DR severity per modified Davis staging
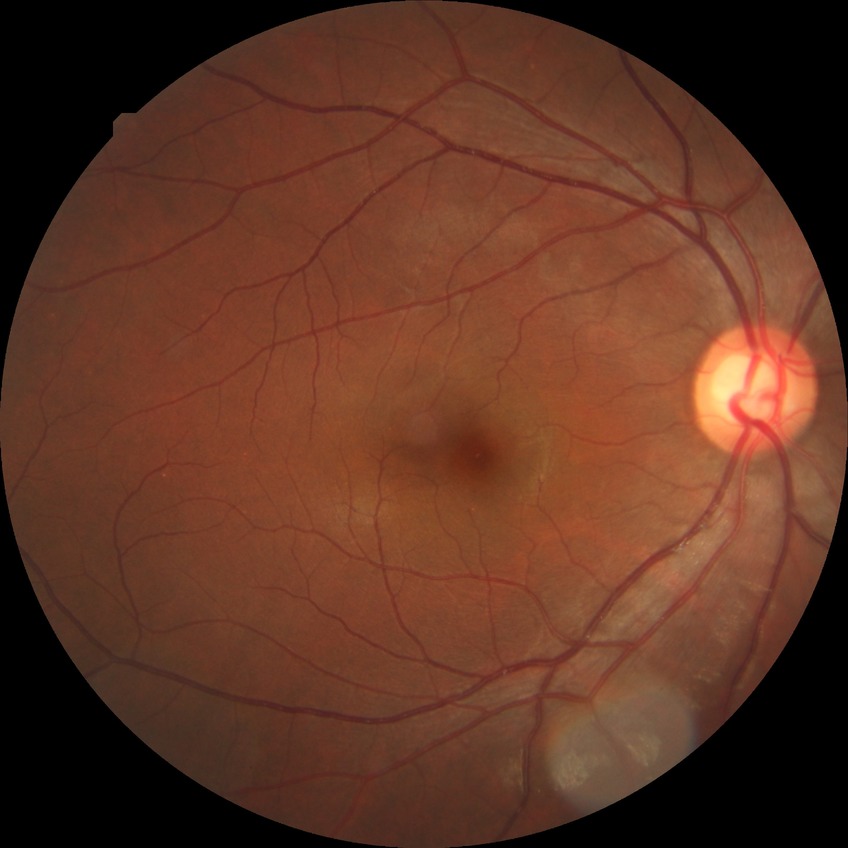 Davis grading is no diabetic retinopathy.